Retinal fundus photograph — 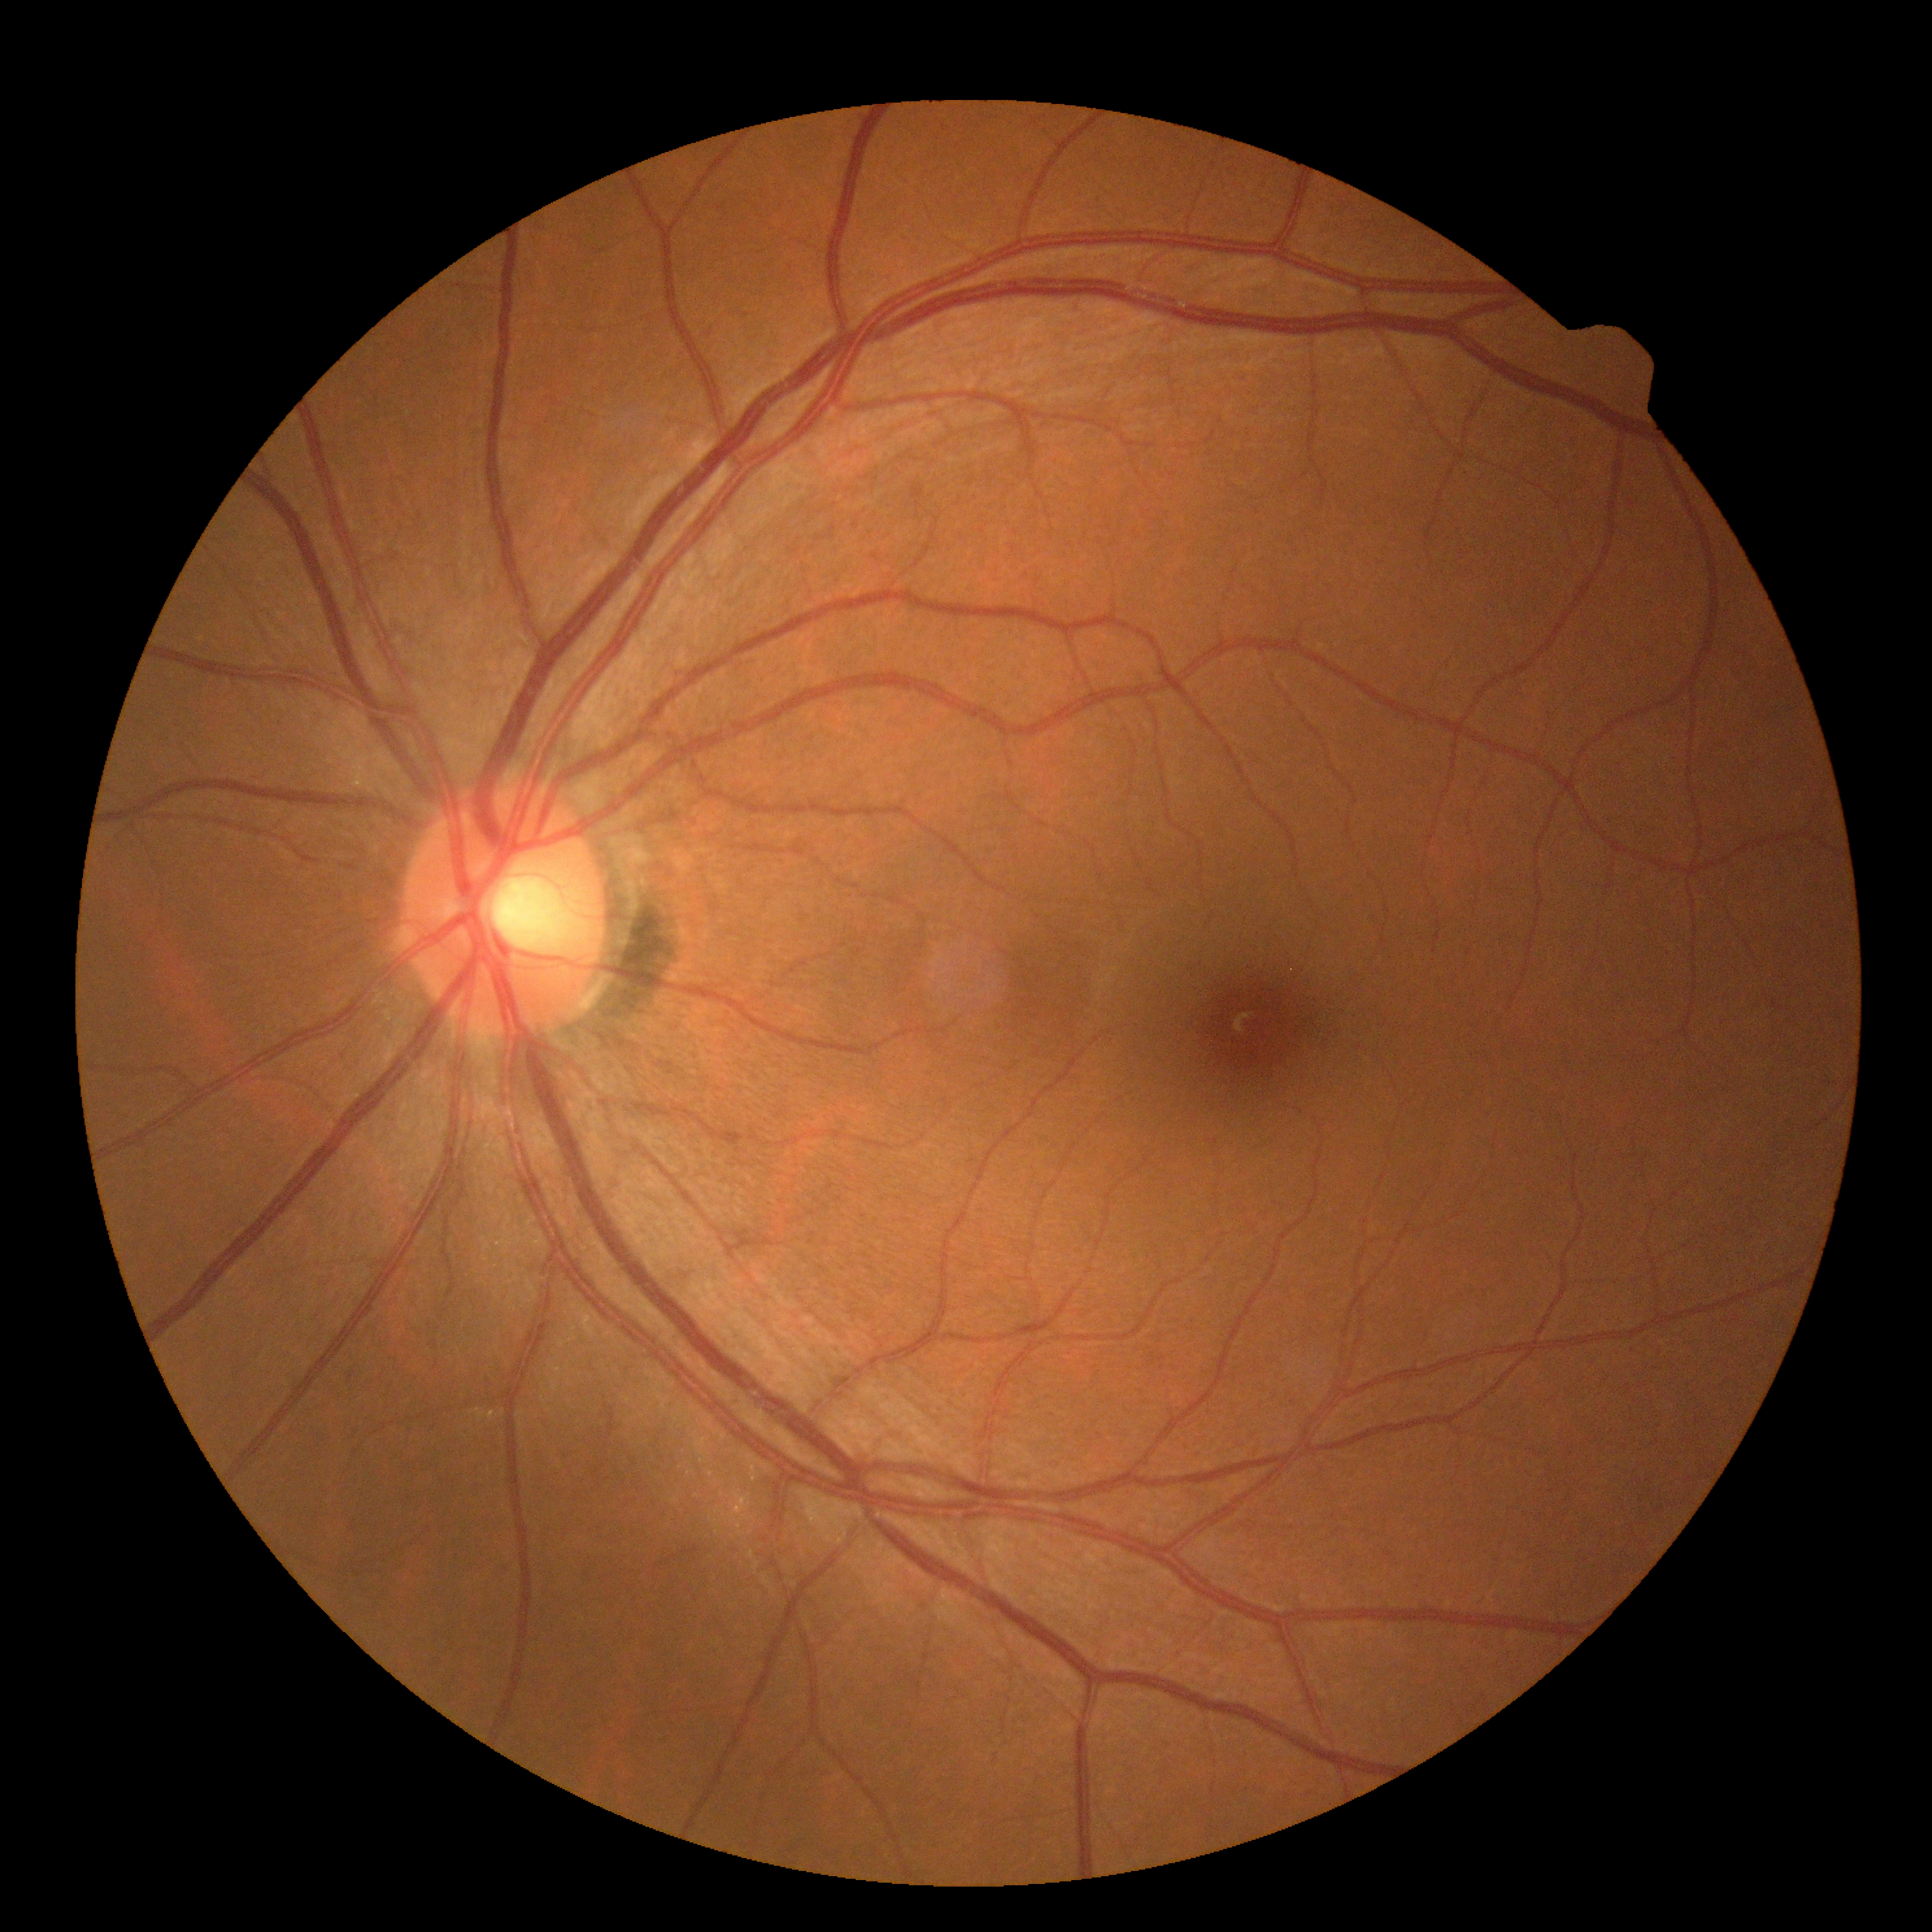 {"dr_grade": "0 (no apparent retinopathy)", "dr_impression": "no apparent DR"}